35° field of view before cropping. Optic disc photograph.
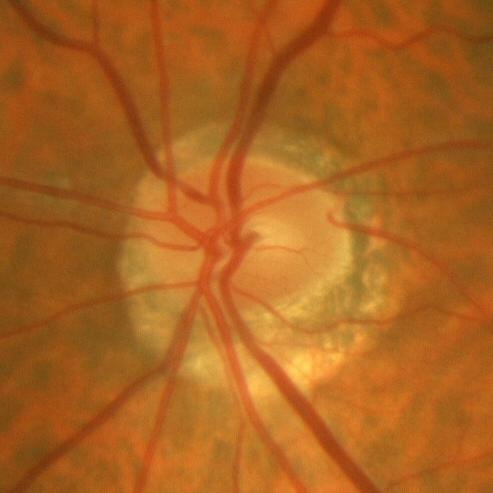 There is evidence of no glaucoma.